Retinal fundus photograph; FOV: 45 degrees:
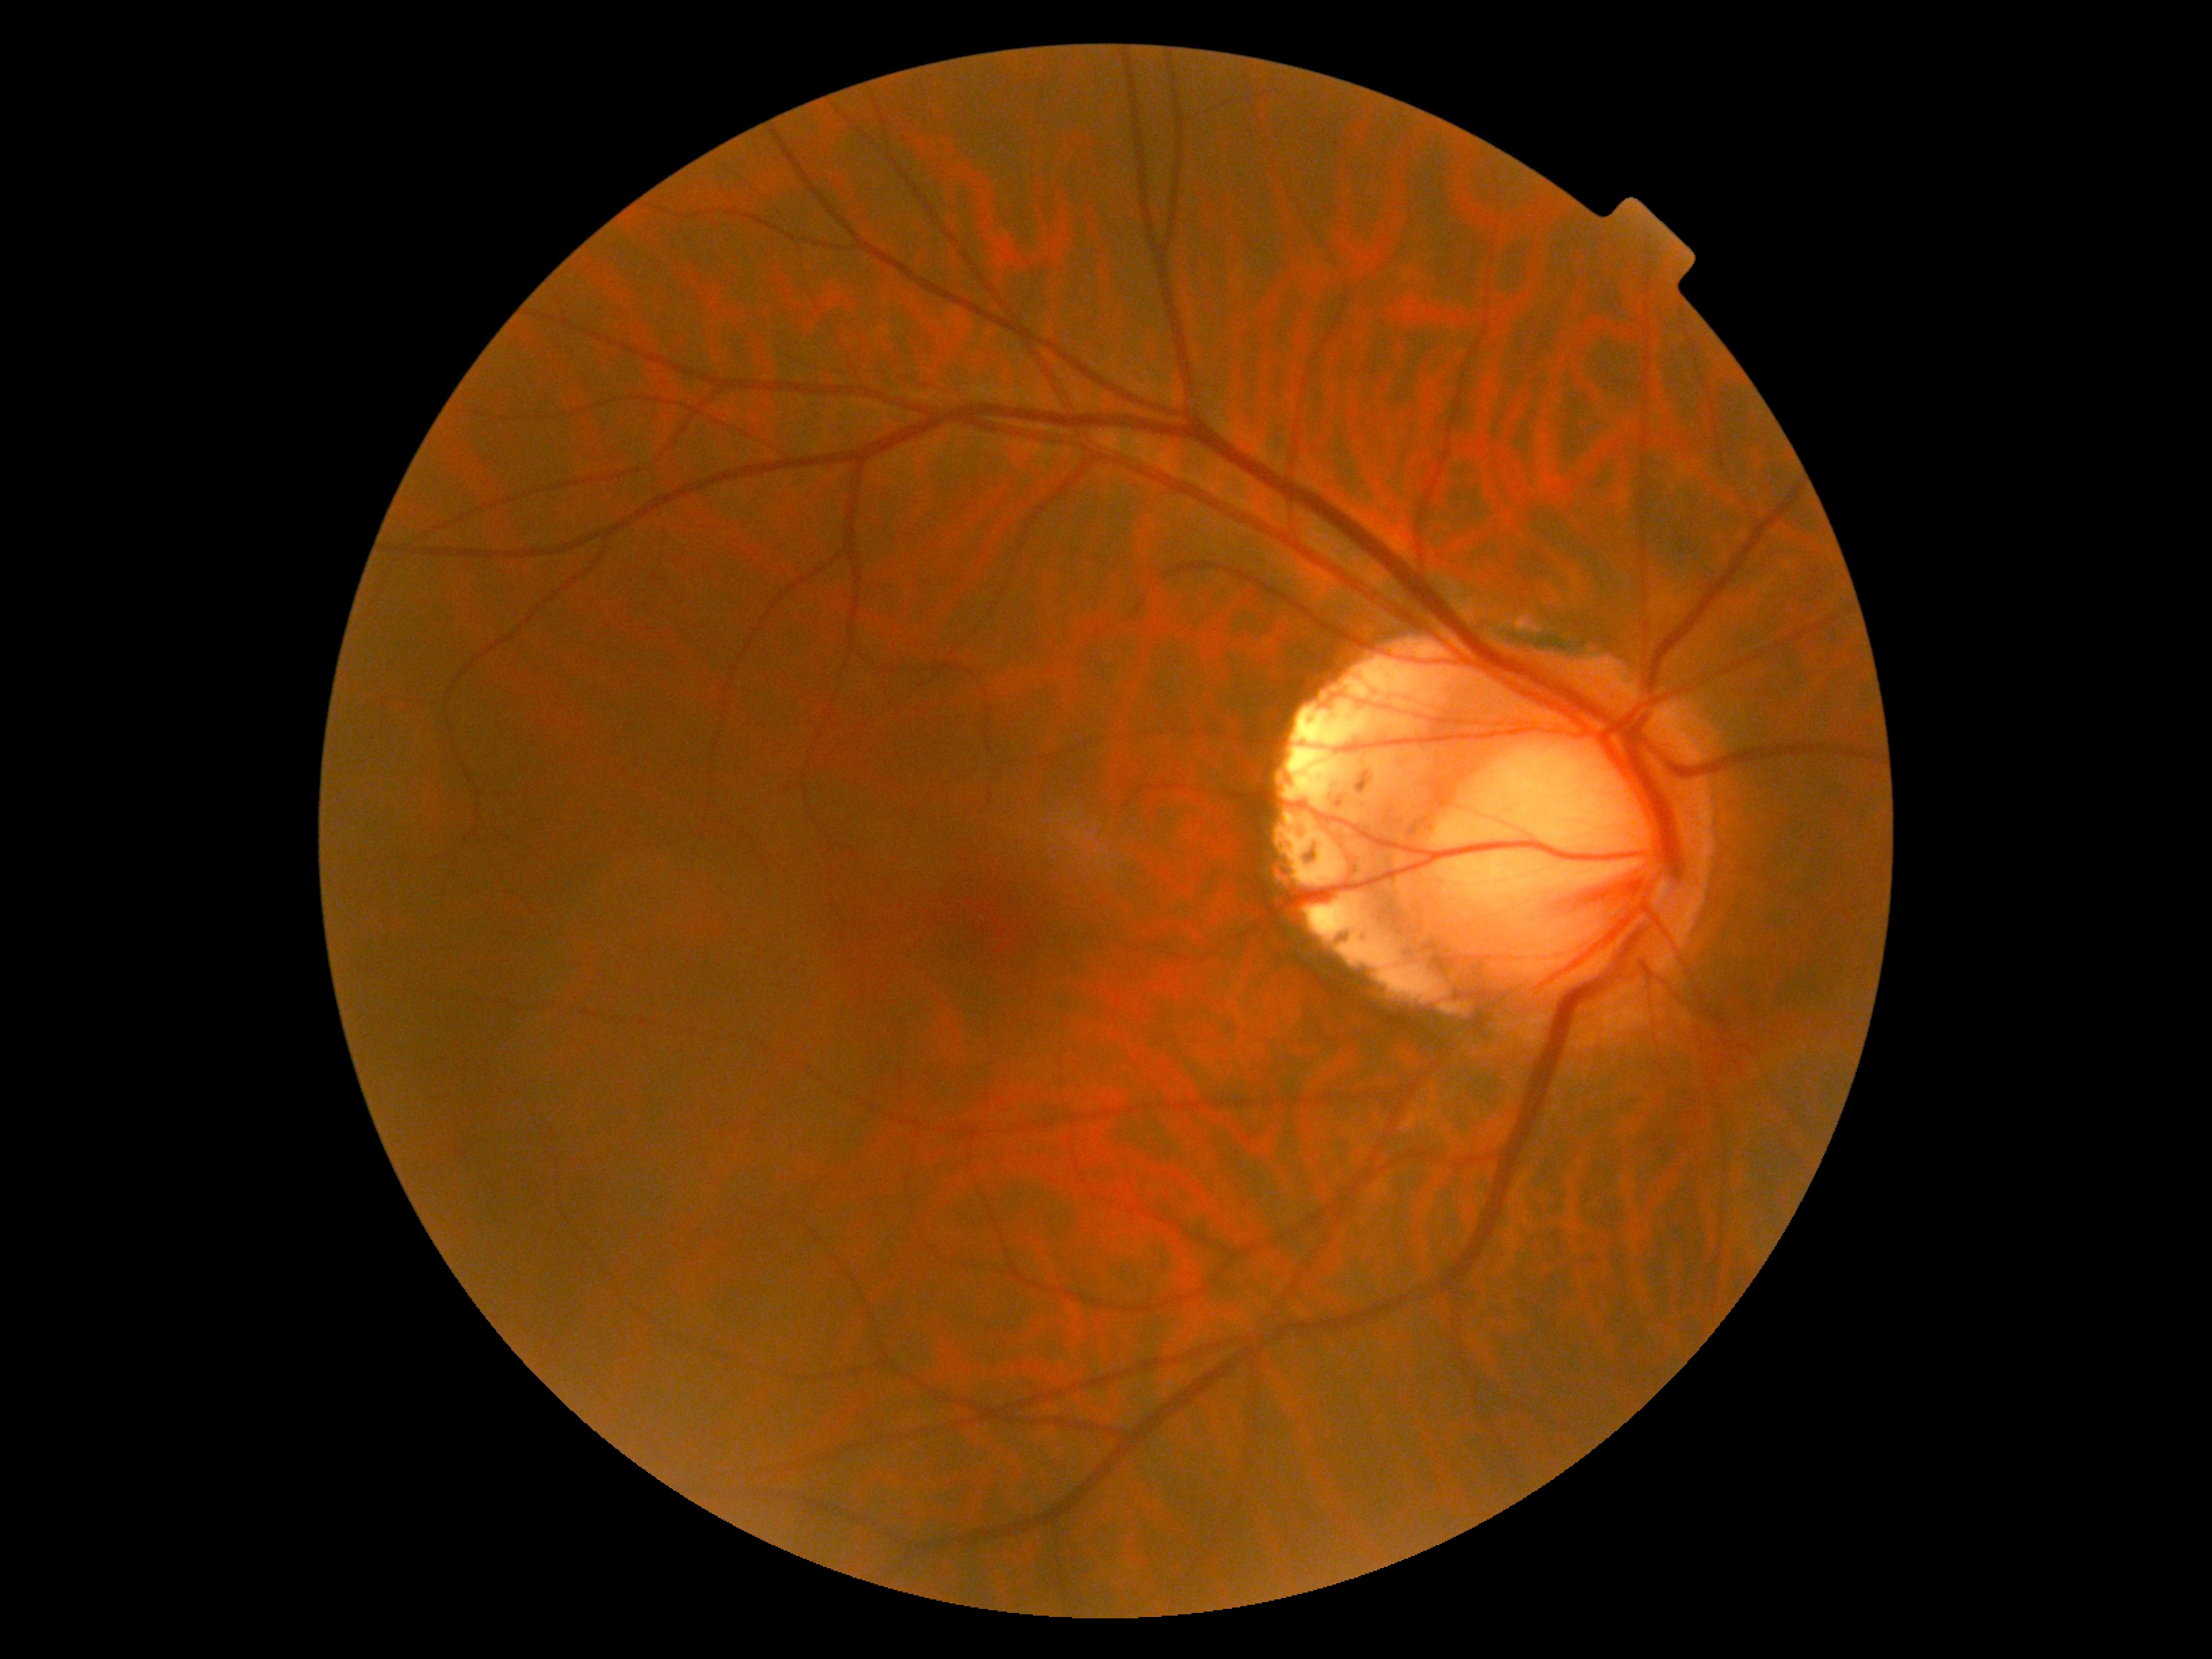

DR grade is 0.